Image size 1932x1932, macula-centered, fundus photo.
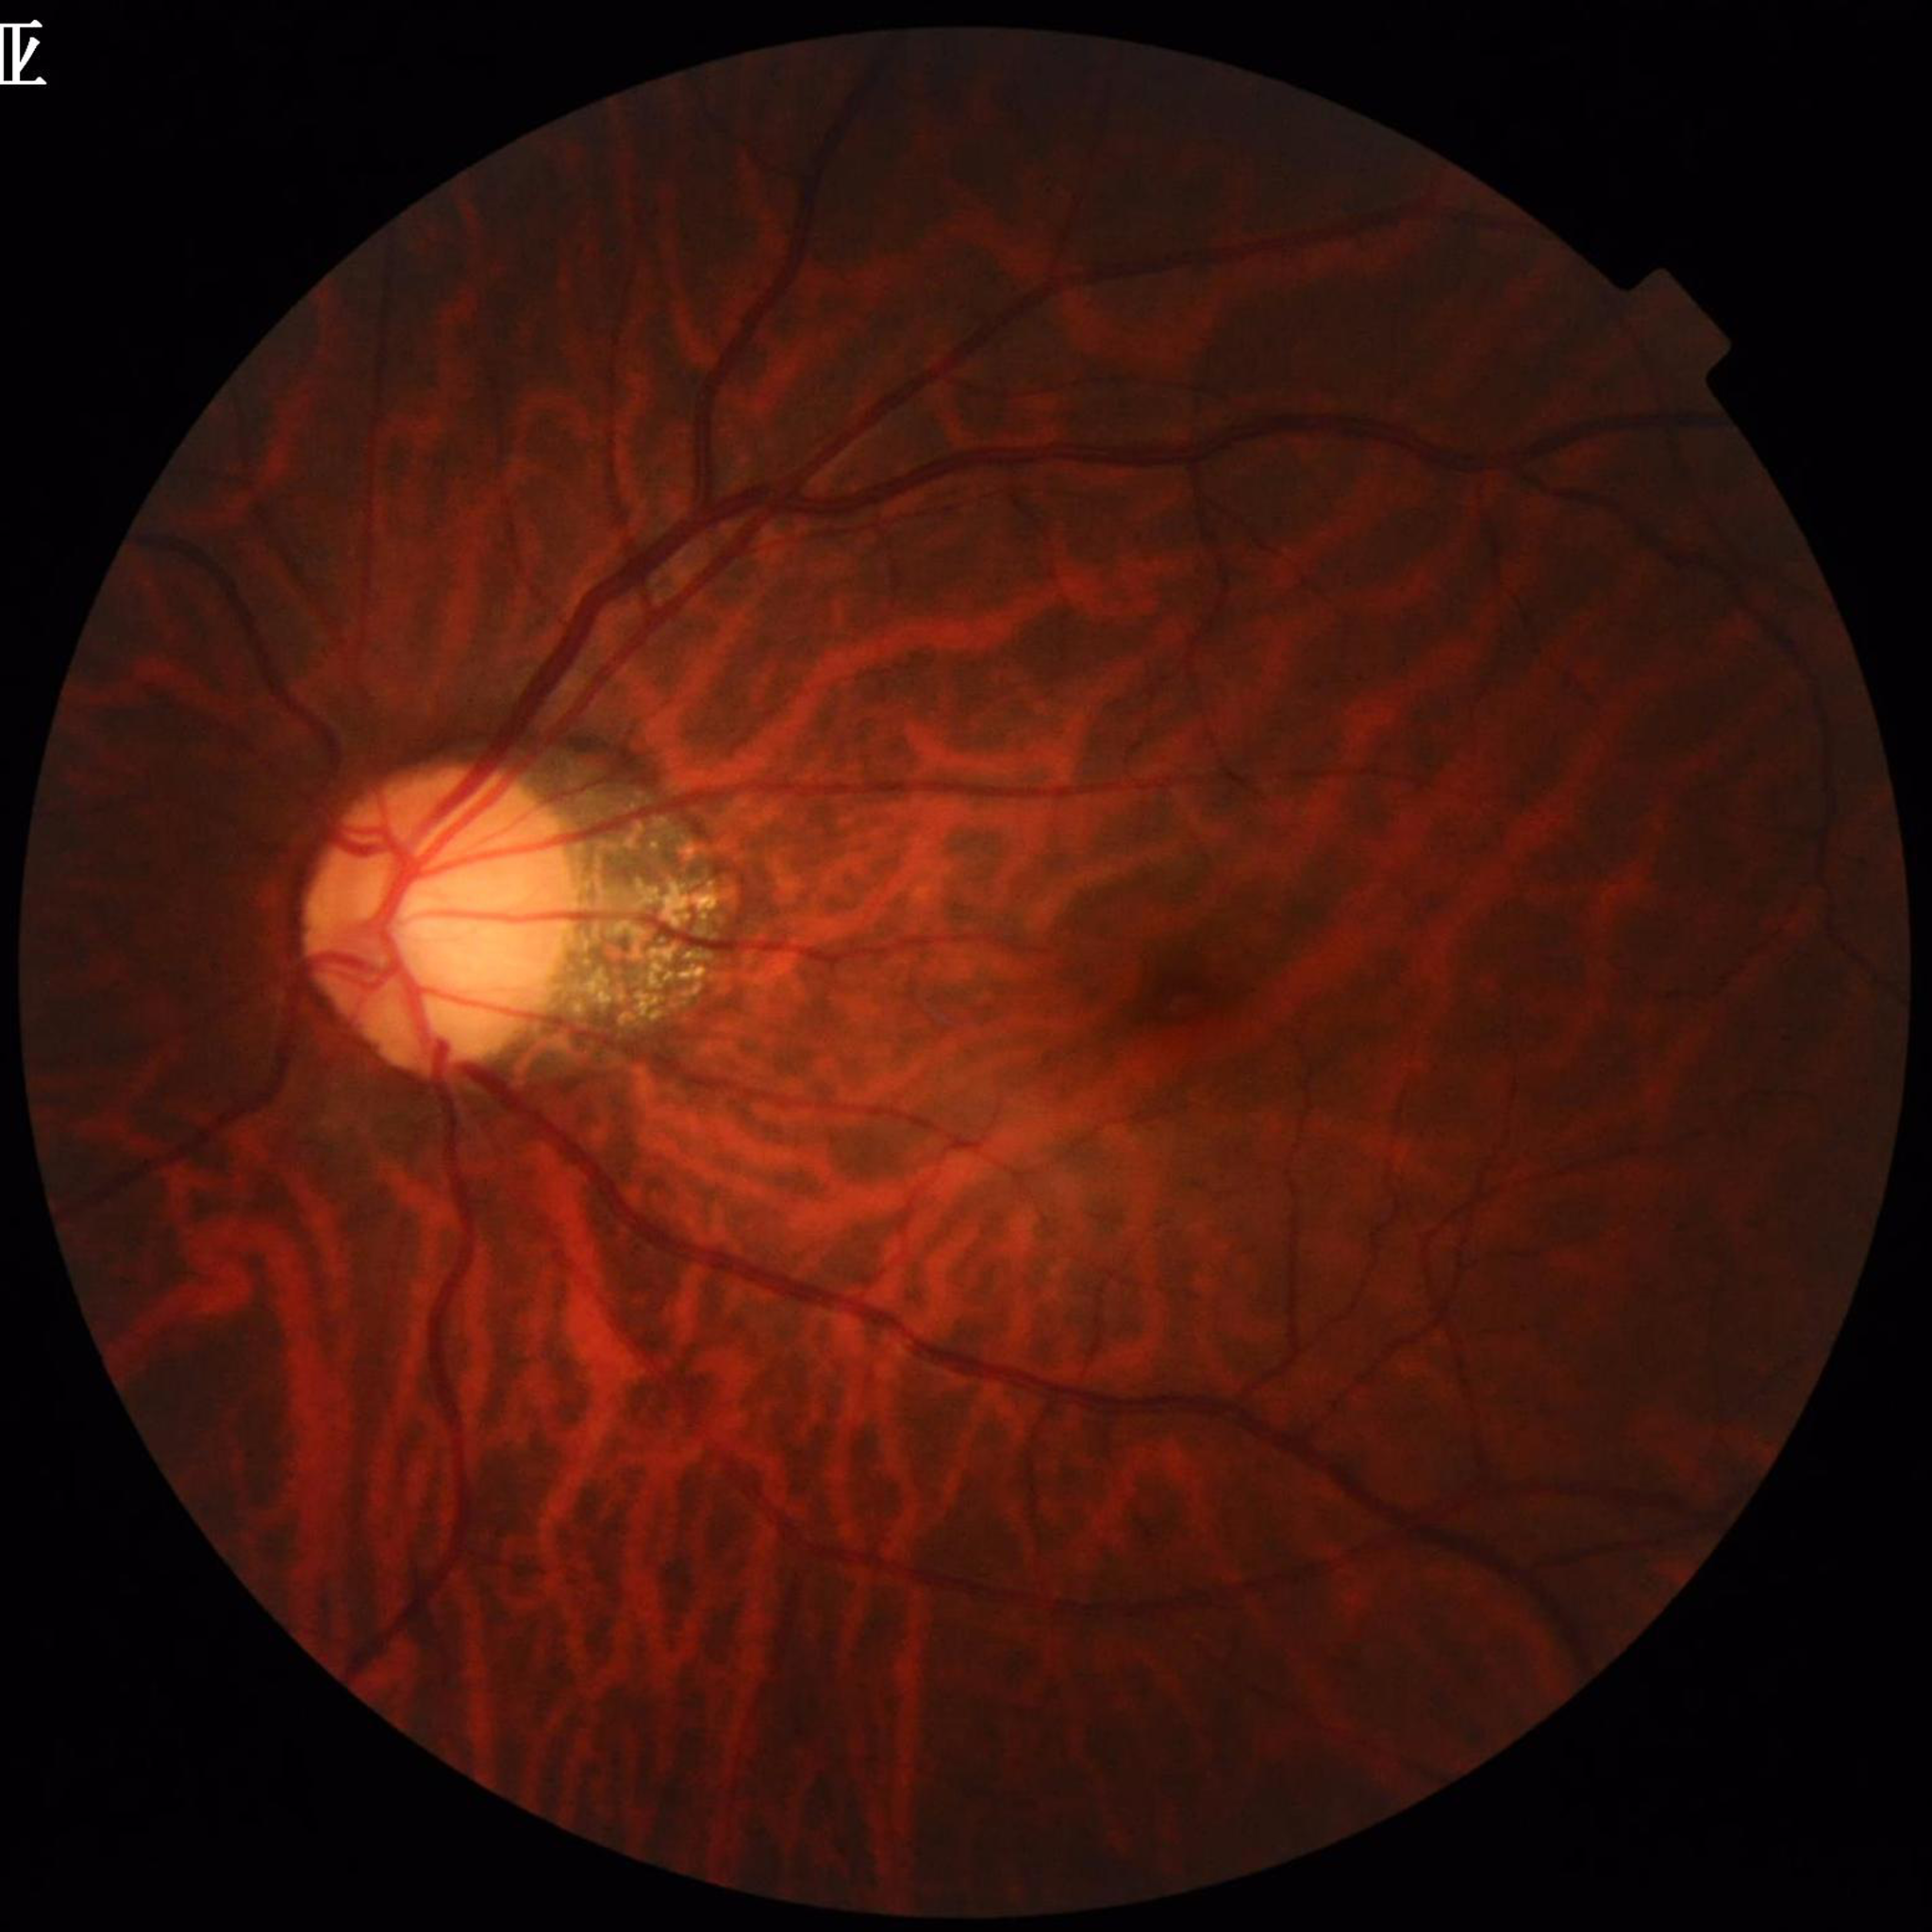
Diagnosed with glaucoma.